1240x1240px. Camera: Phoenix ICON (100° FOV). Phoenix ICON wide-field infant fundus image: 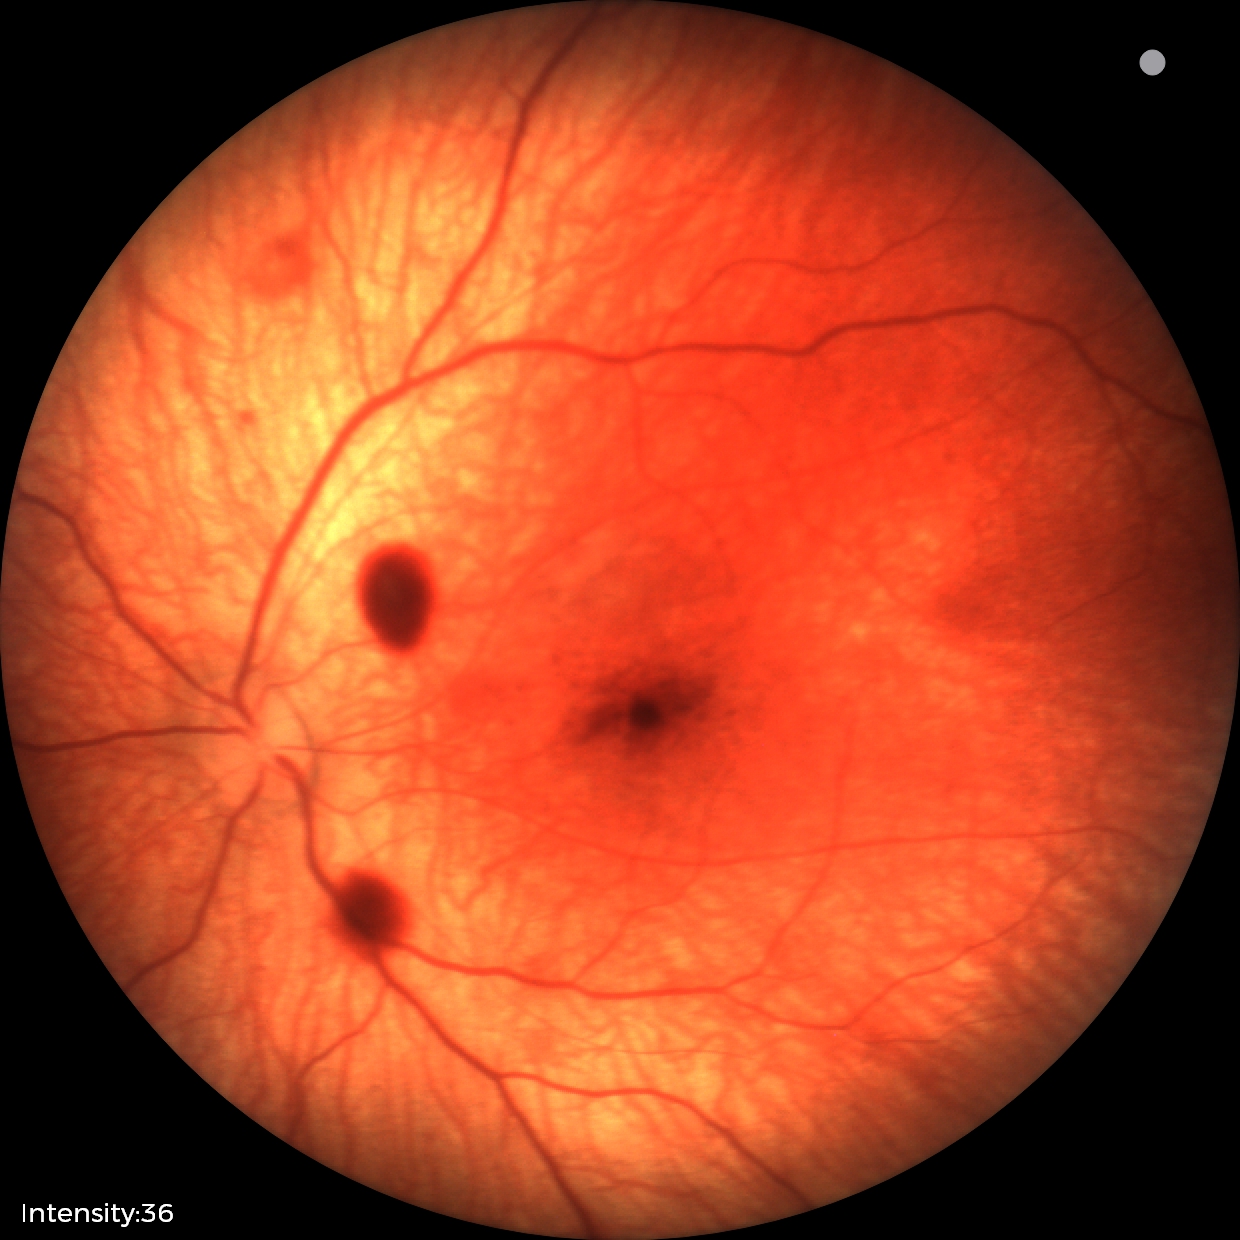
Q: What is the screening diagnosis?
A: retinal hemorrhages